200-degree field of view — 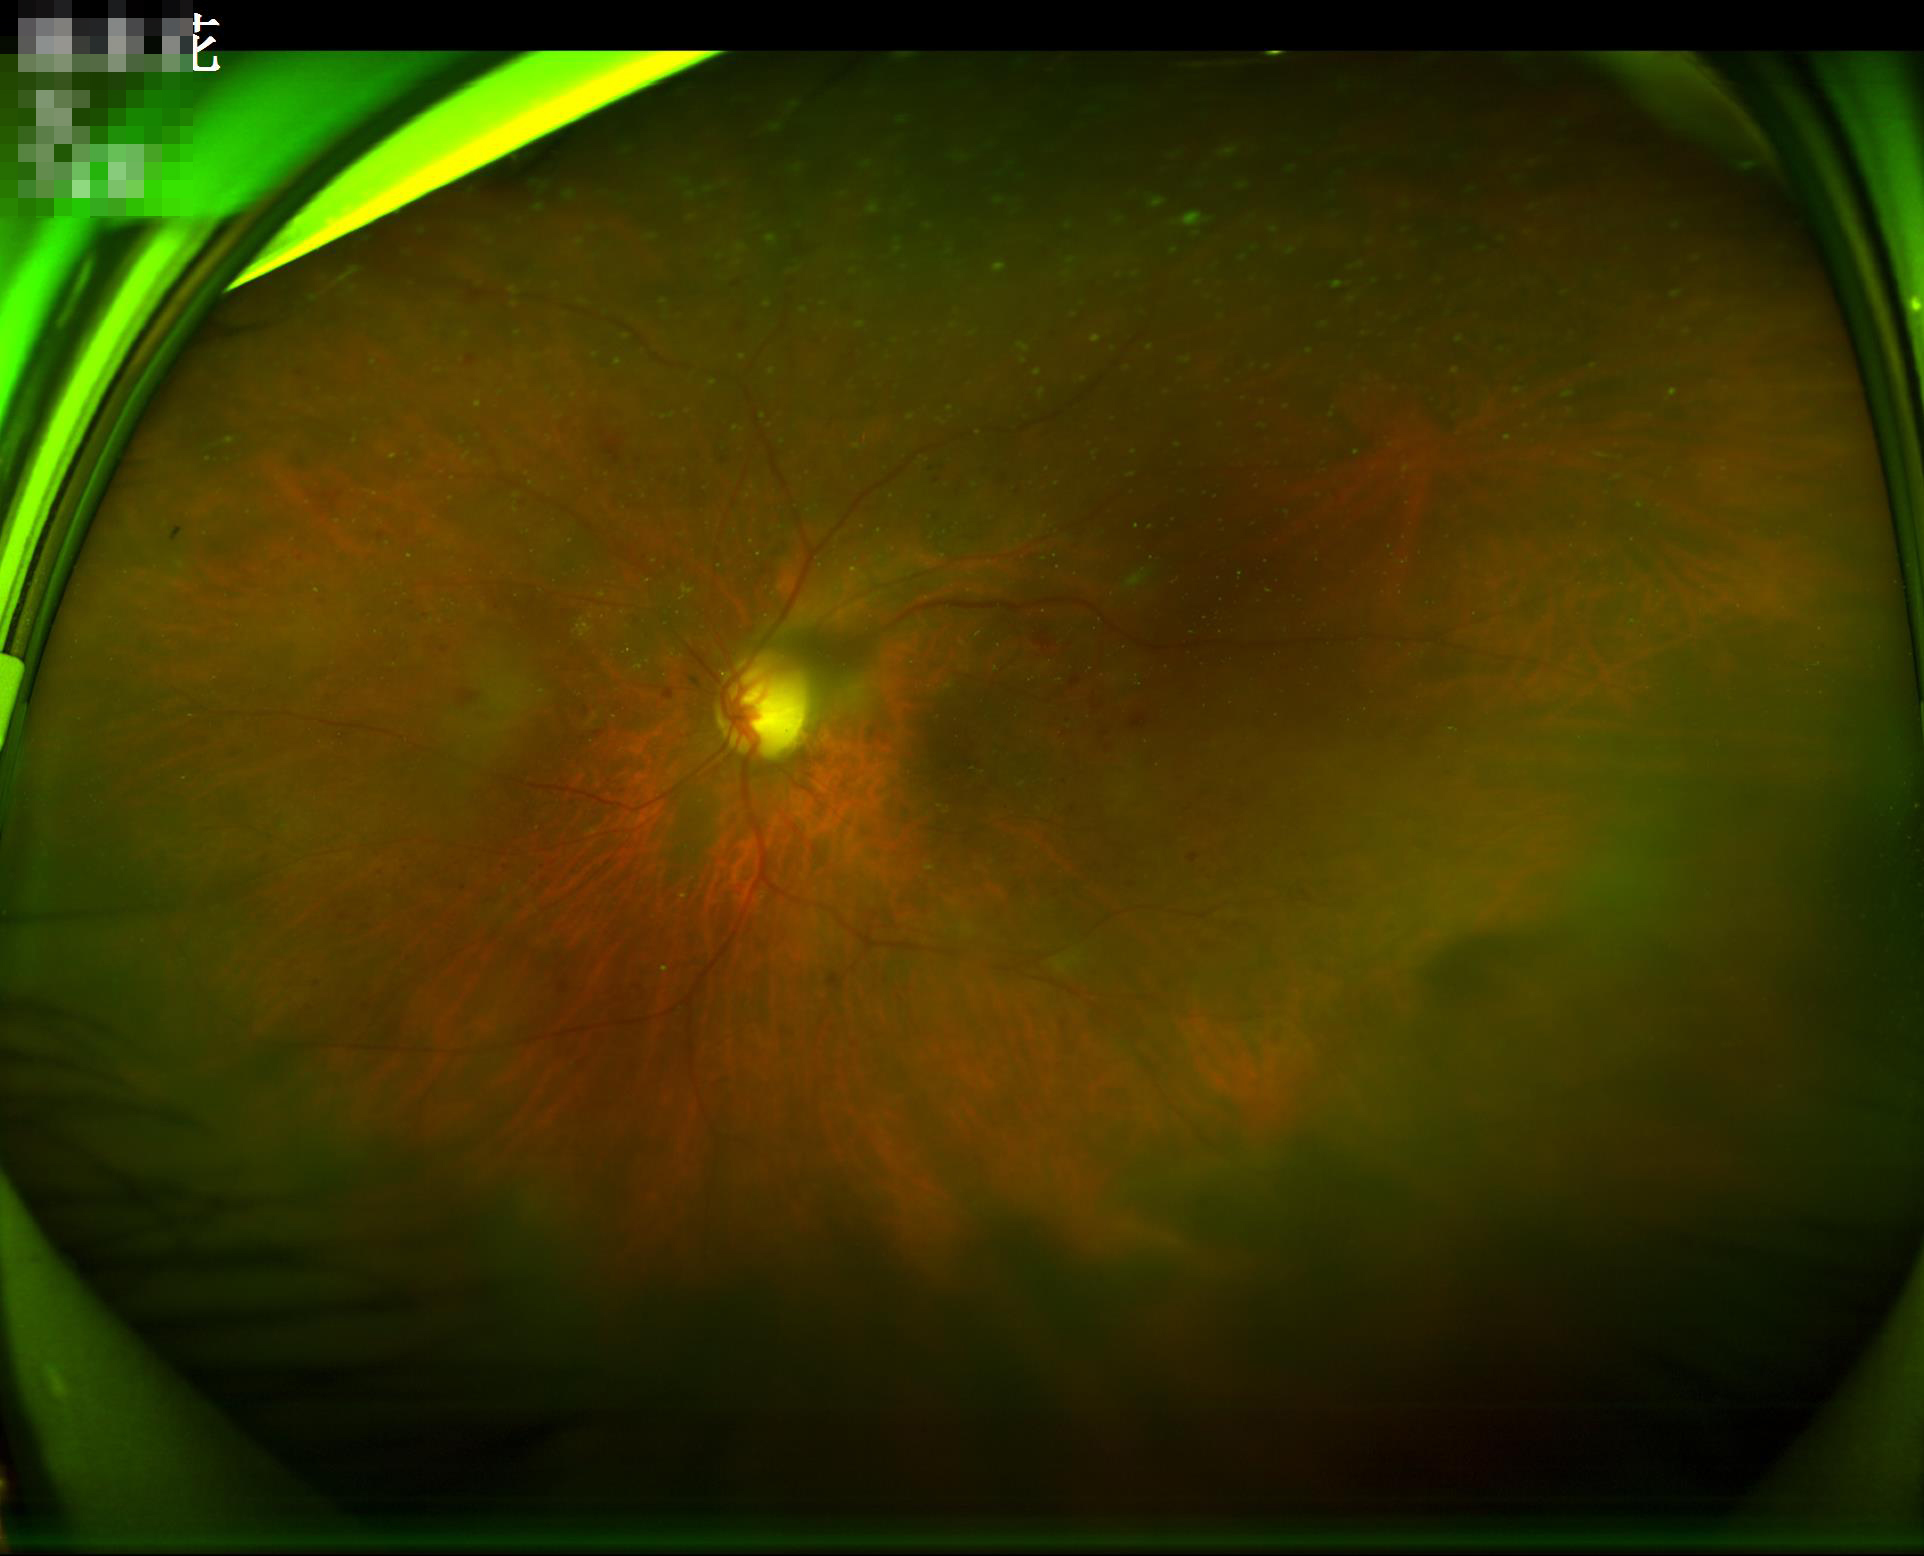

Contrast is good.
Poor illumination with uneven exposure.
Reduced sharpness with visible blur.
Image quality is suboptimal.